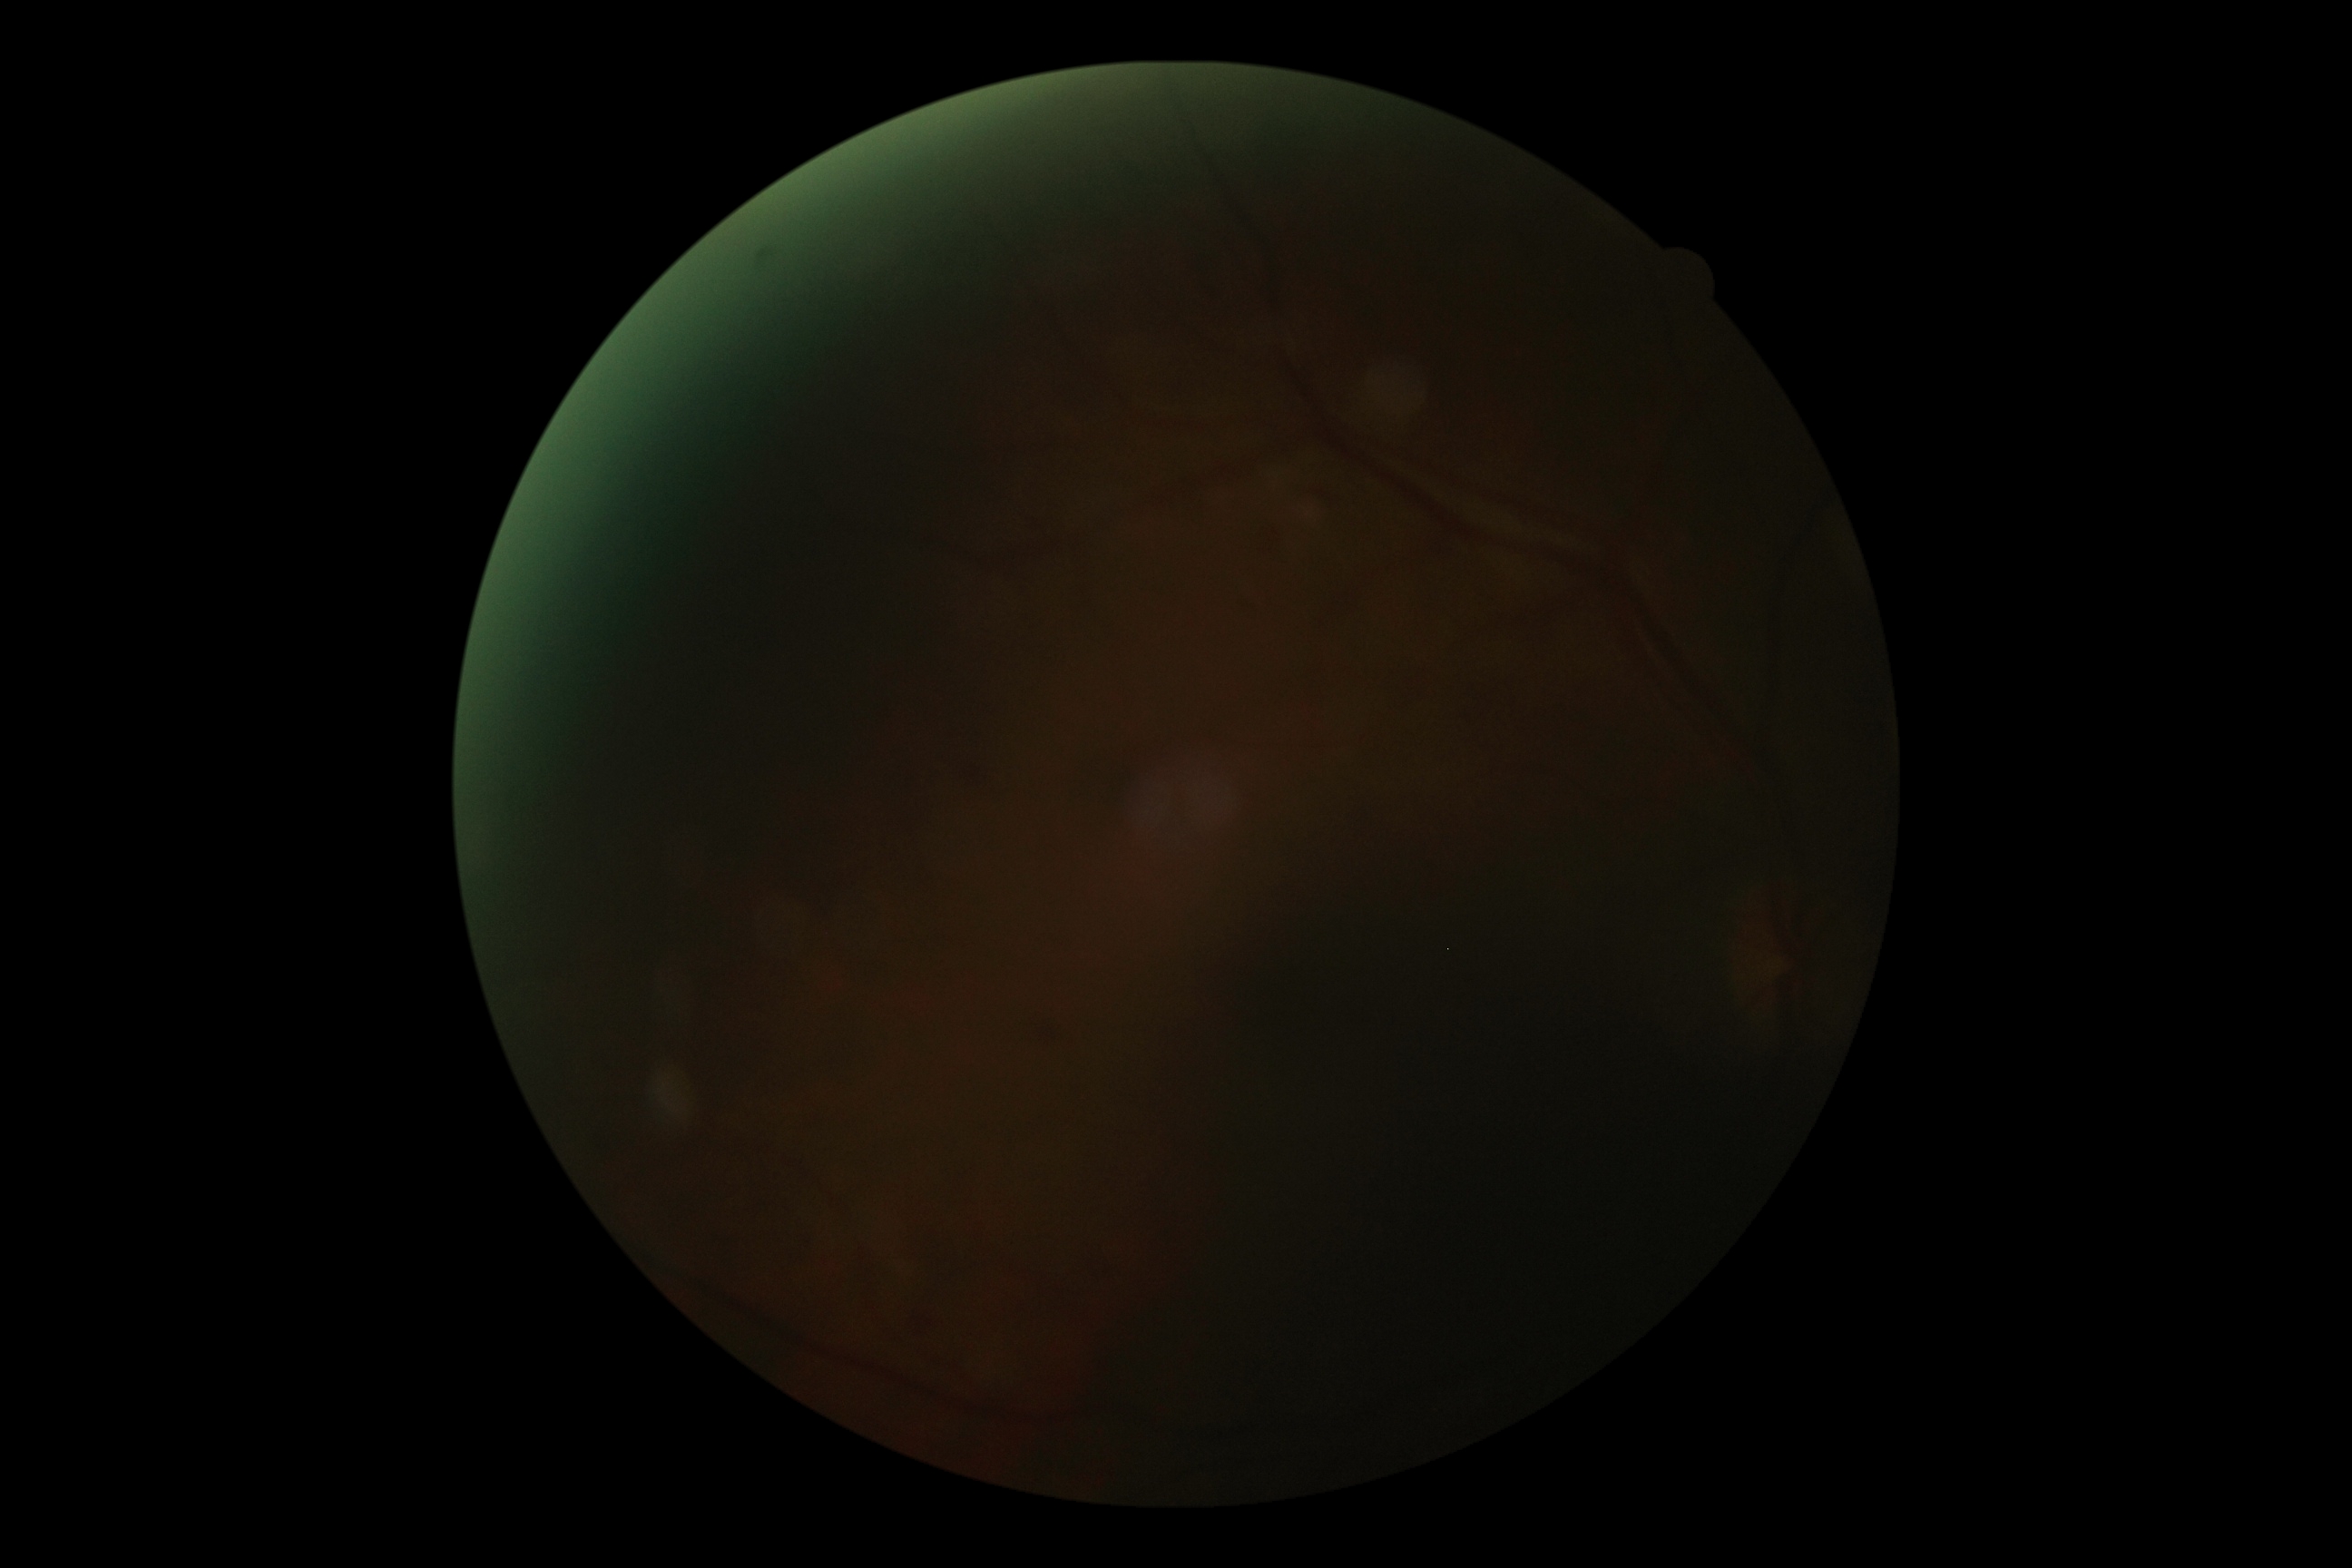 diabetic retinopathy (DR) = ungradable.